Retinal fundus photograph: 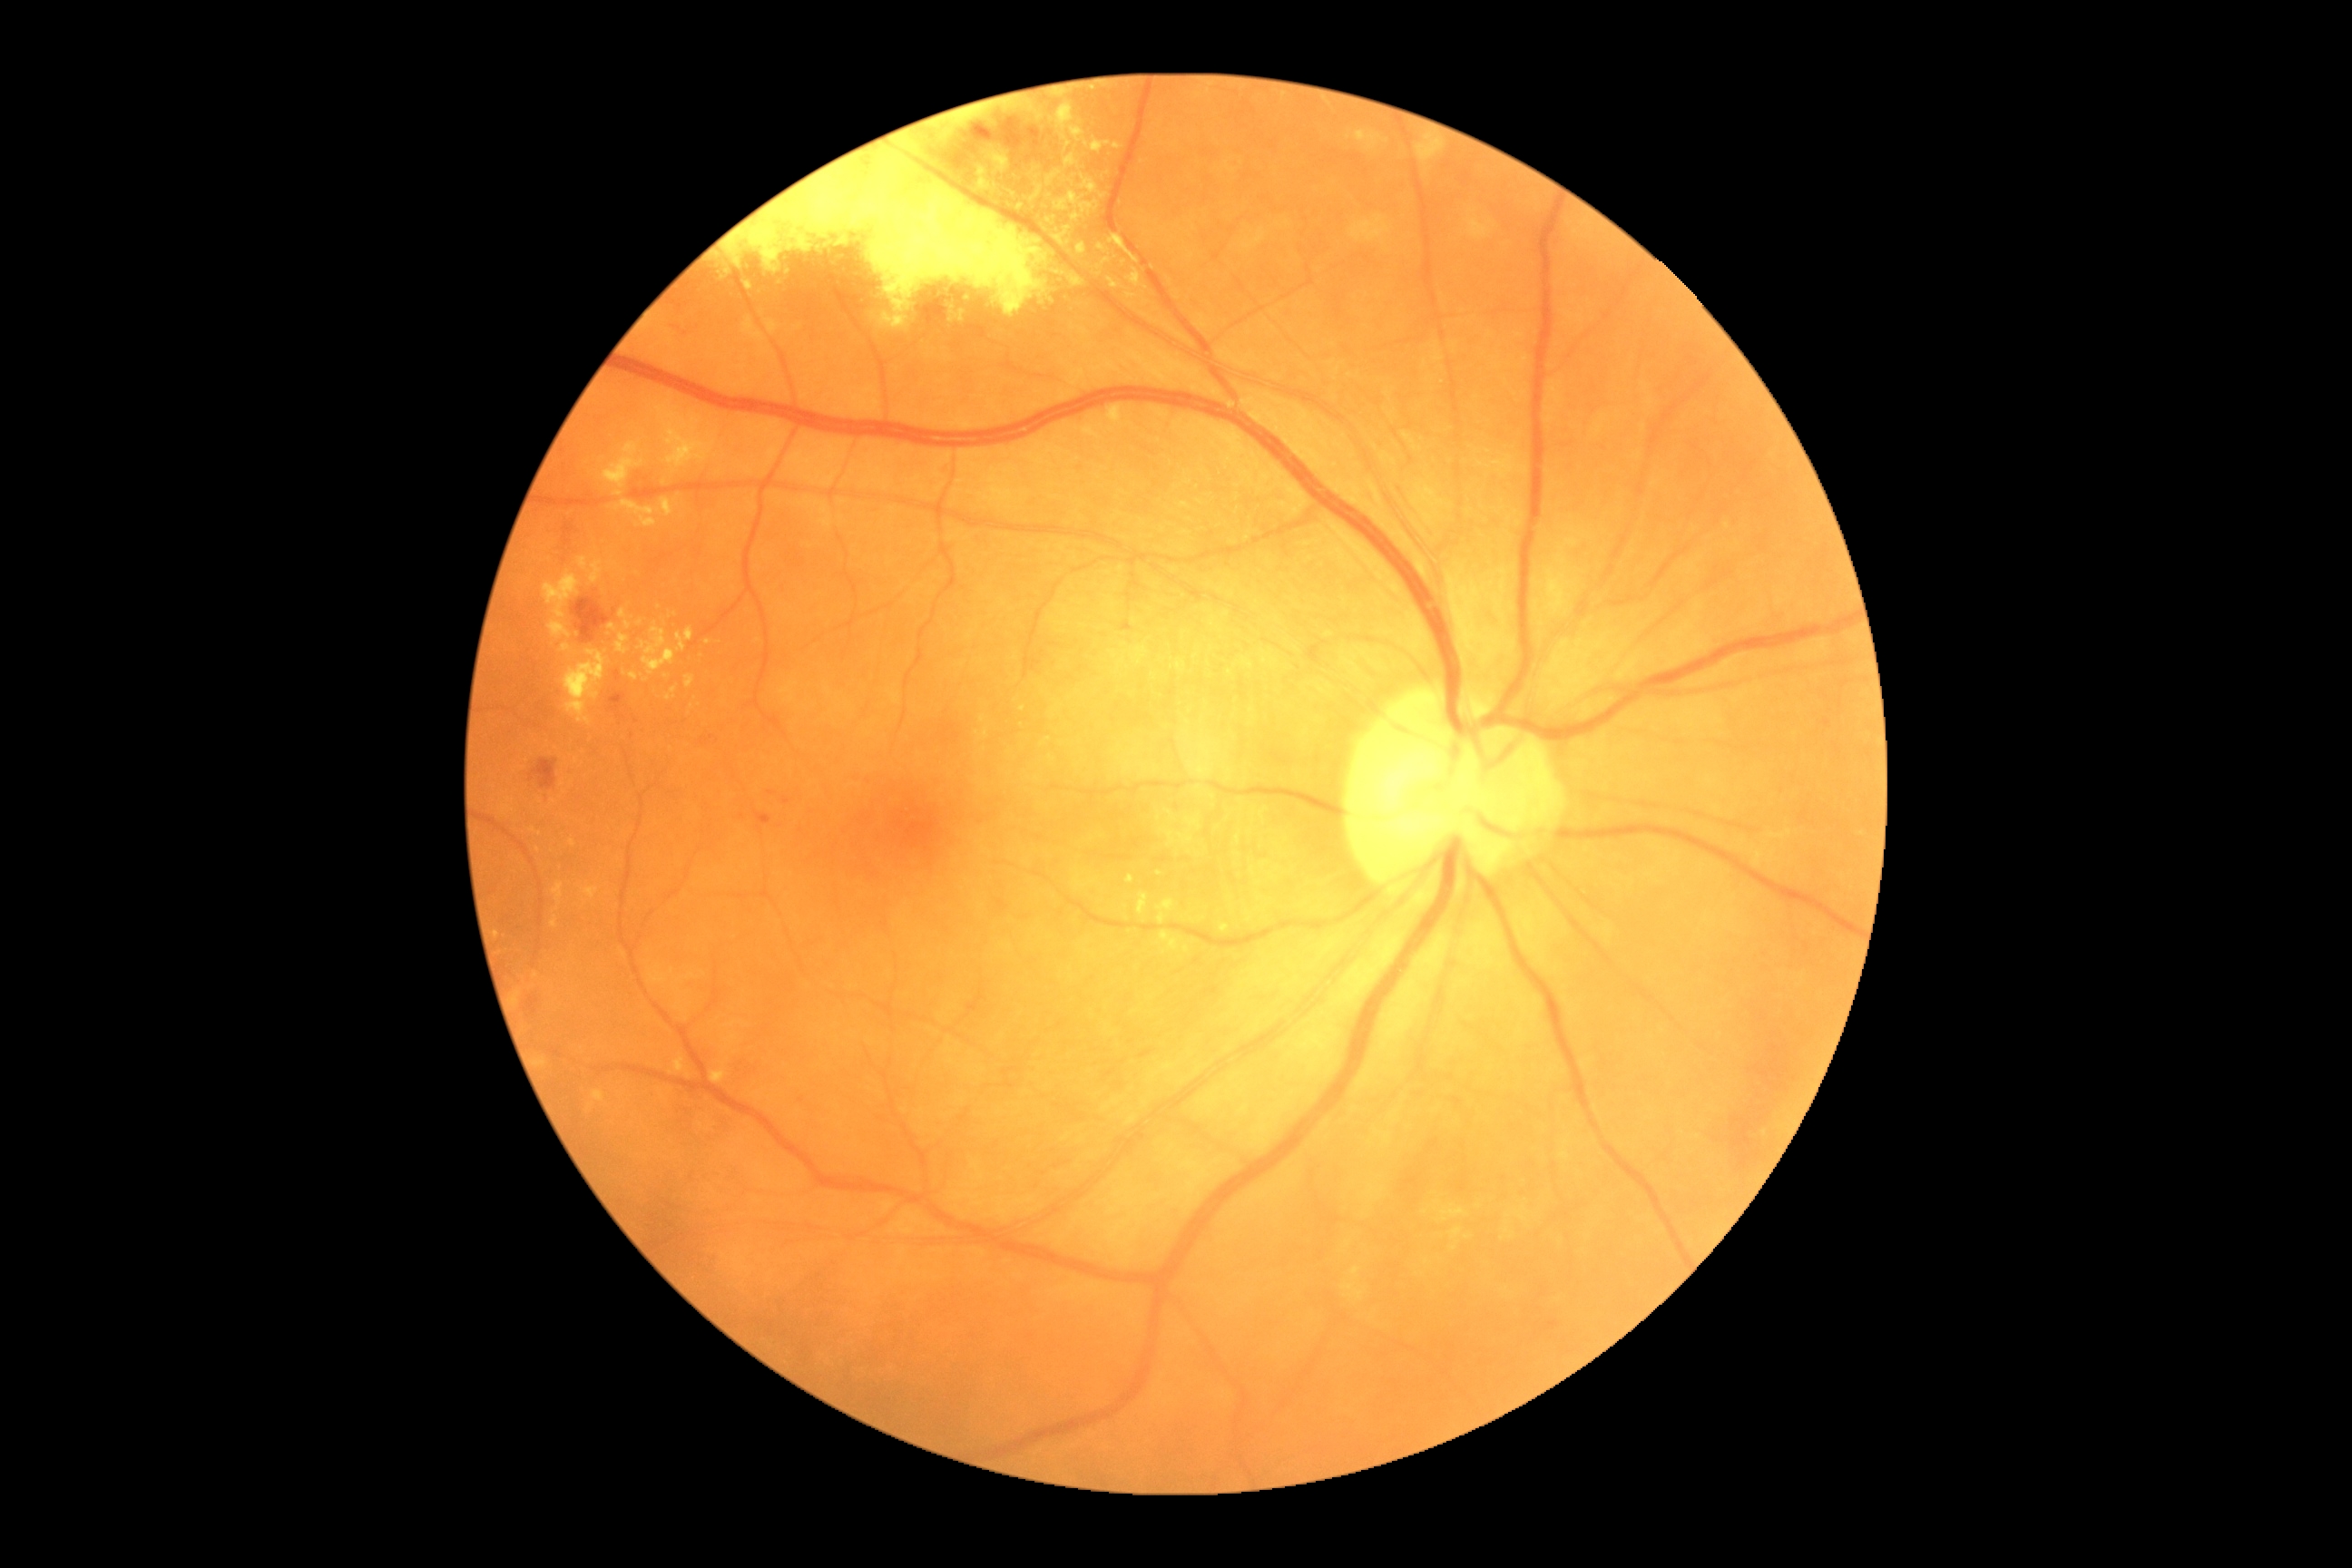

DR grade is moderate NPDR (2). The retinopathy is classified as non-proliferative diabetic retinopathy.